Image size 2102x1736 — 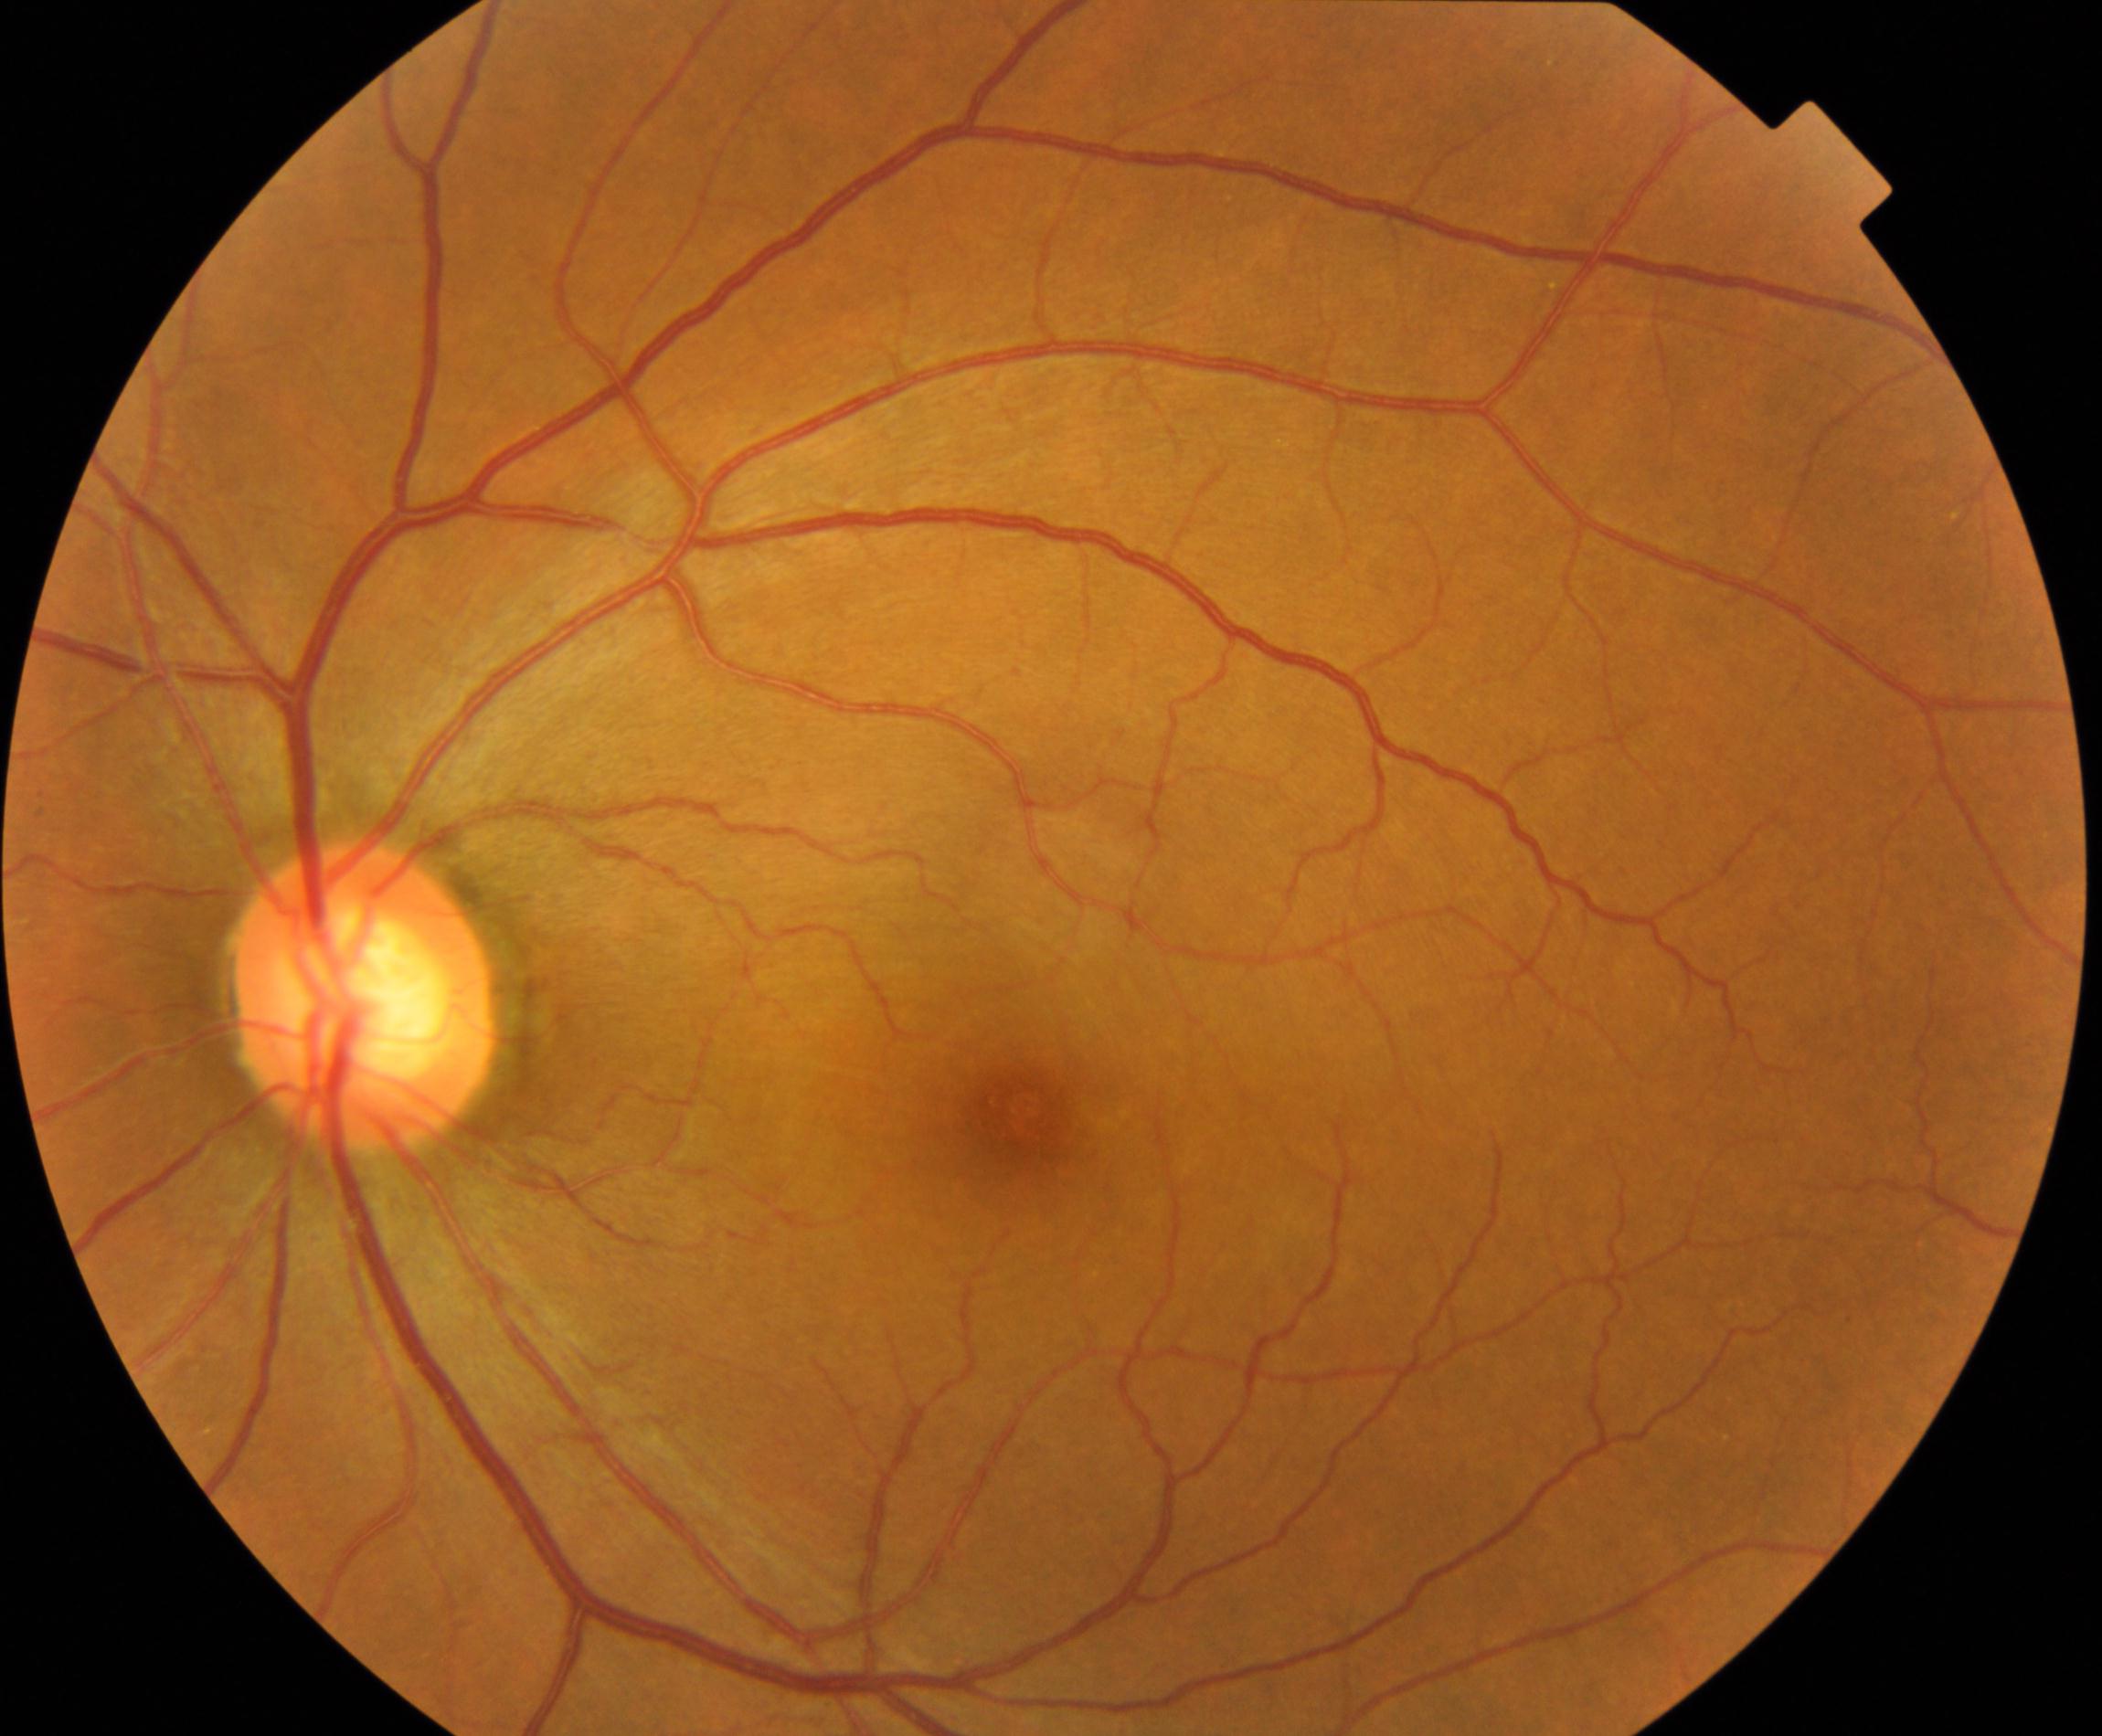
Classification: large optic cup.